2212x1659; color fundus photograph; 45° field of view:
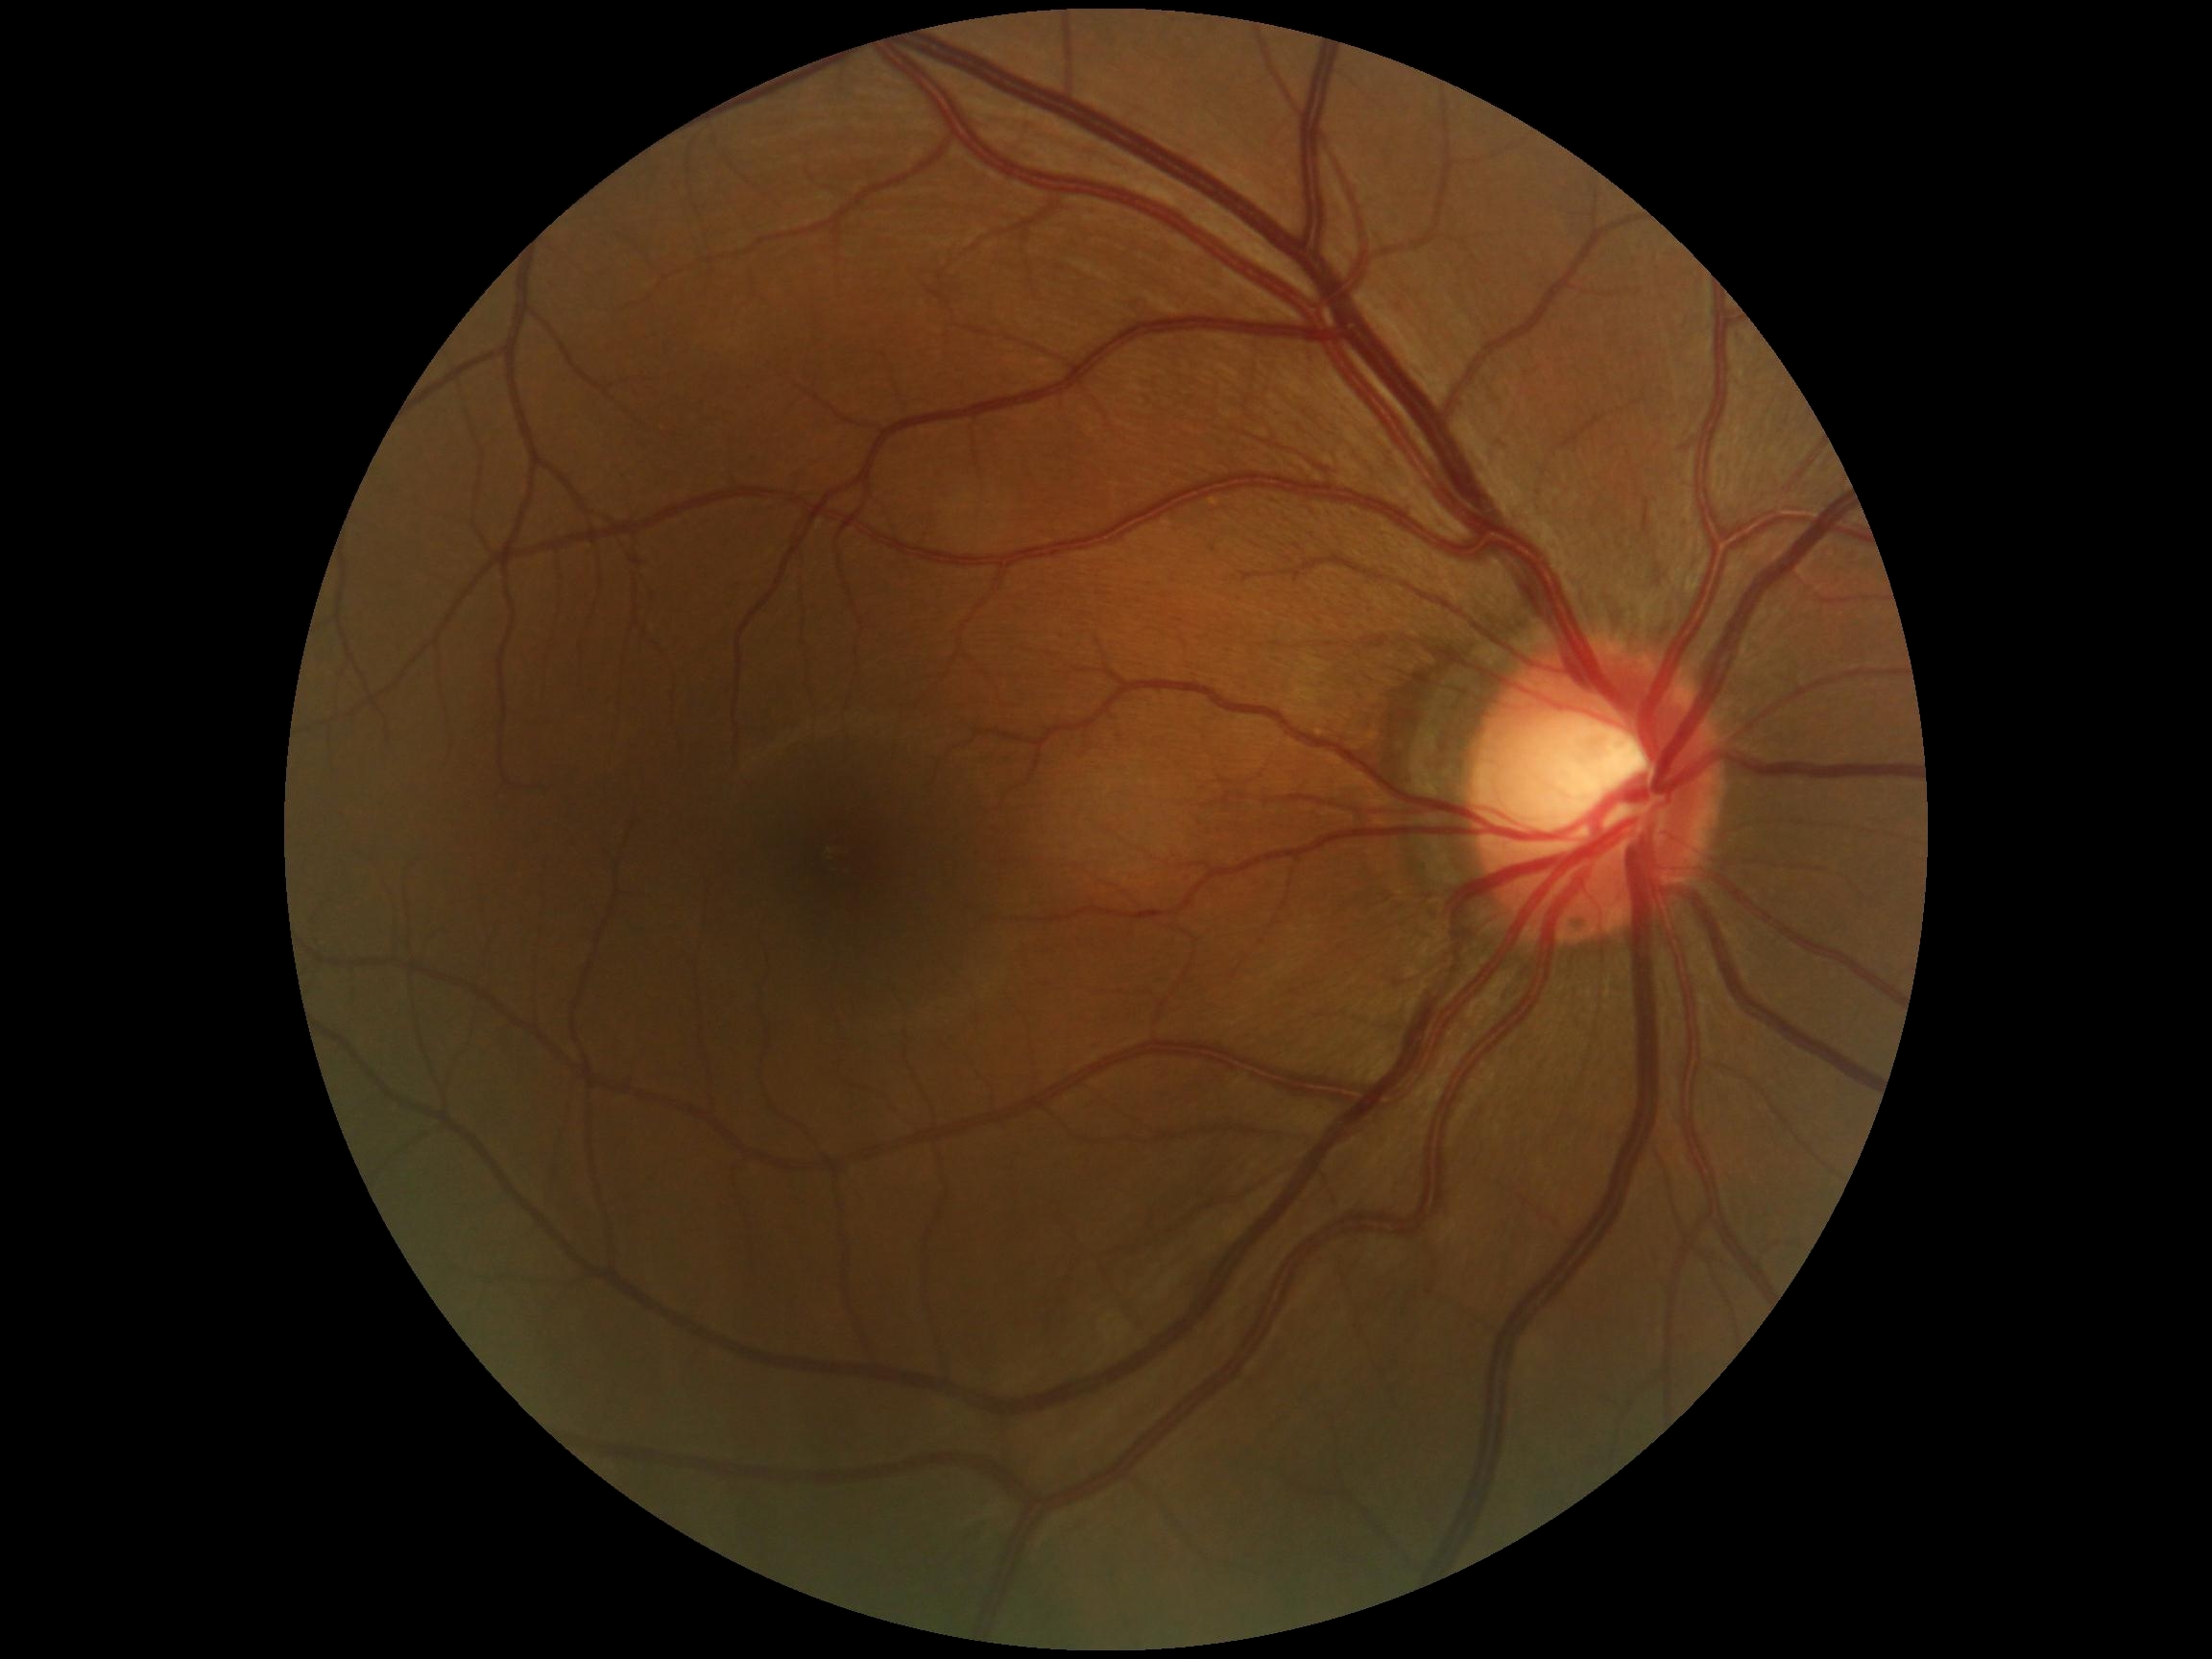
DR stage: no apparent retinopathy (grade 0).
No diabetic retinal disease findings.